Camera: Clarity RetCam 3 (130° FOV) · pediatric retinal photograph (wide-field) · 640 x 480 pixels: 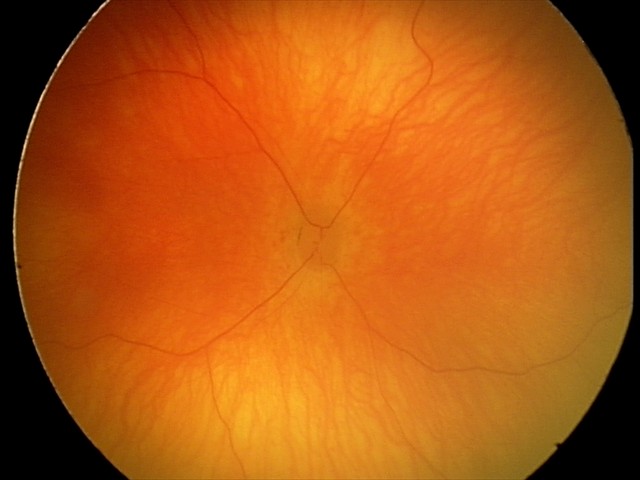
Screening examination with no abnormal retinal findings.